Camera: Clarity RetCam 3 (130° FOV); wide-field contact fundus photograph of an infant.
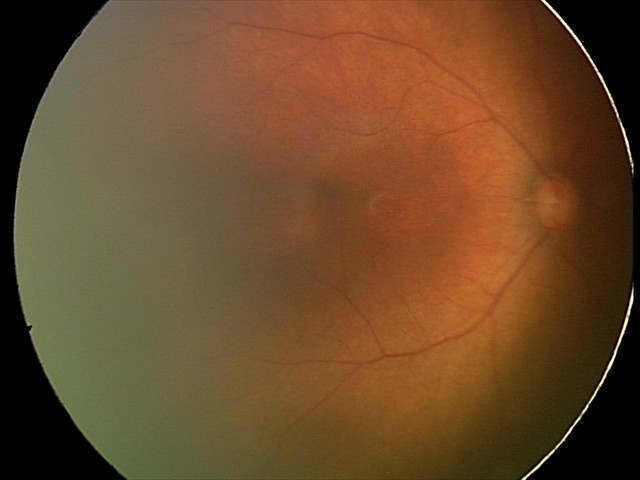

Physiological retinal appearance for postconceptual age.